Ultra-widefield fundus photograph: 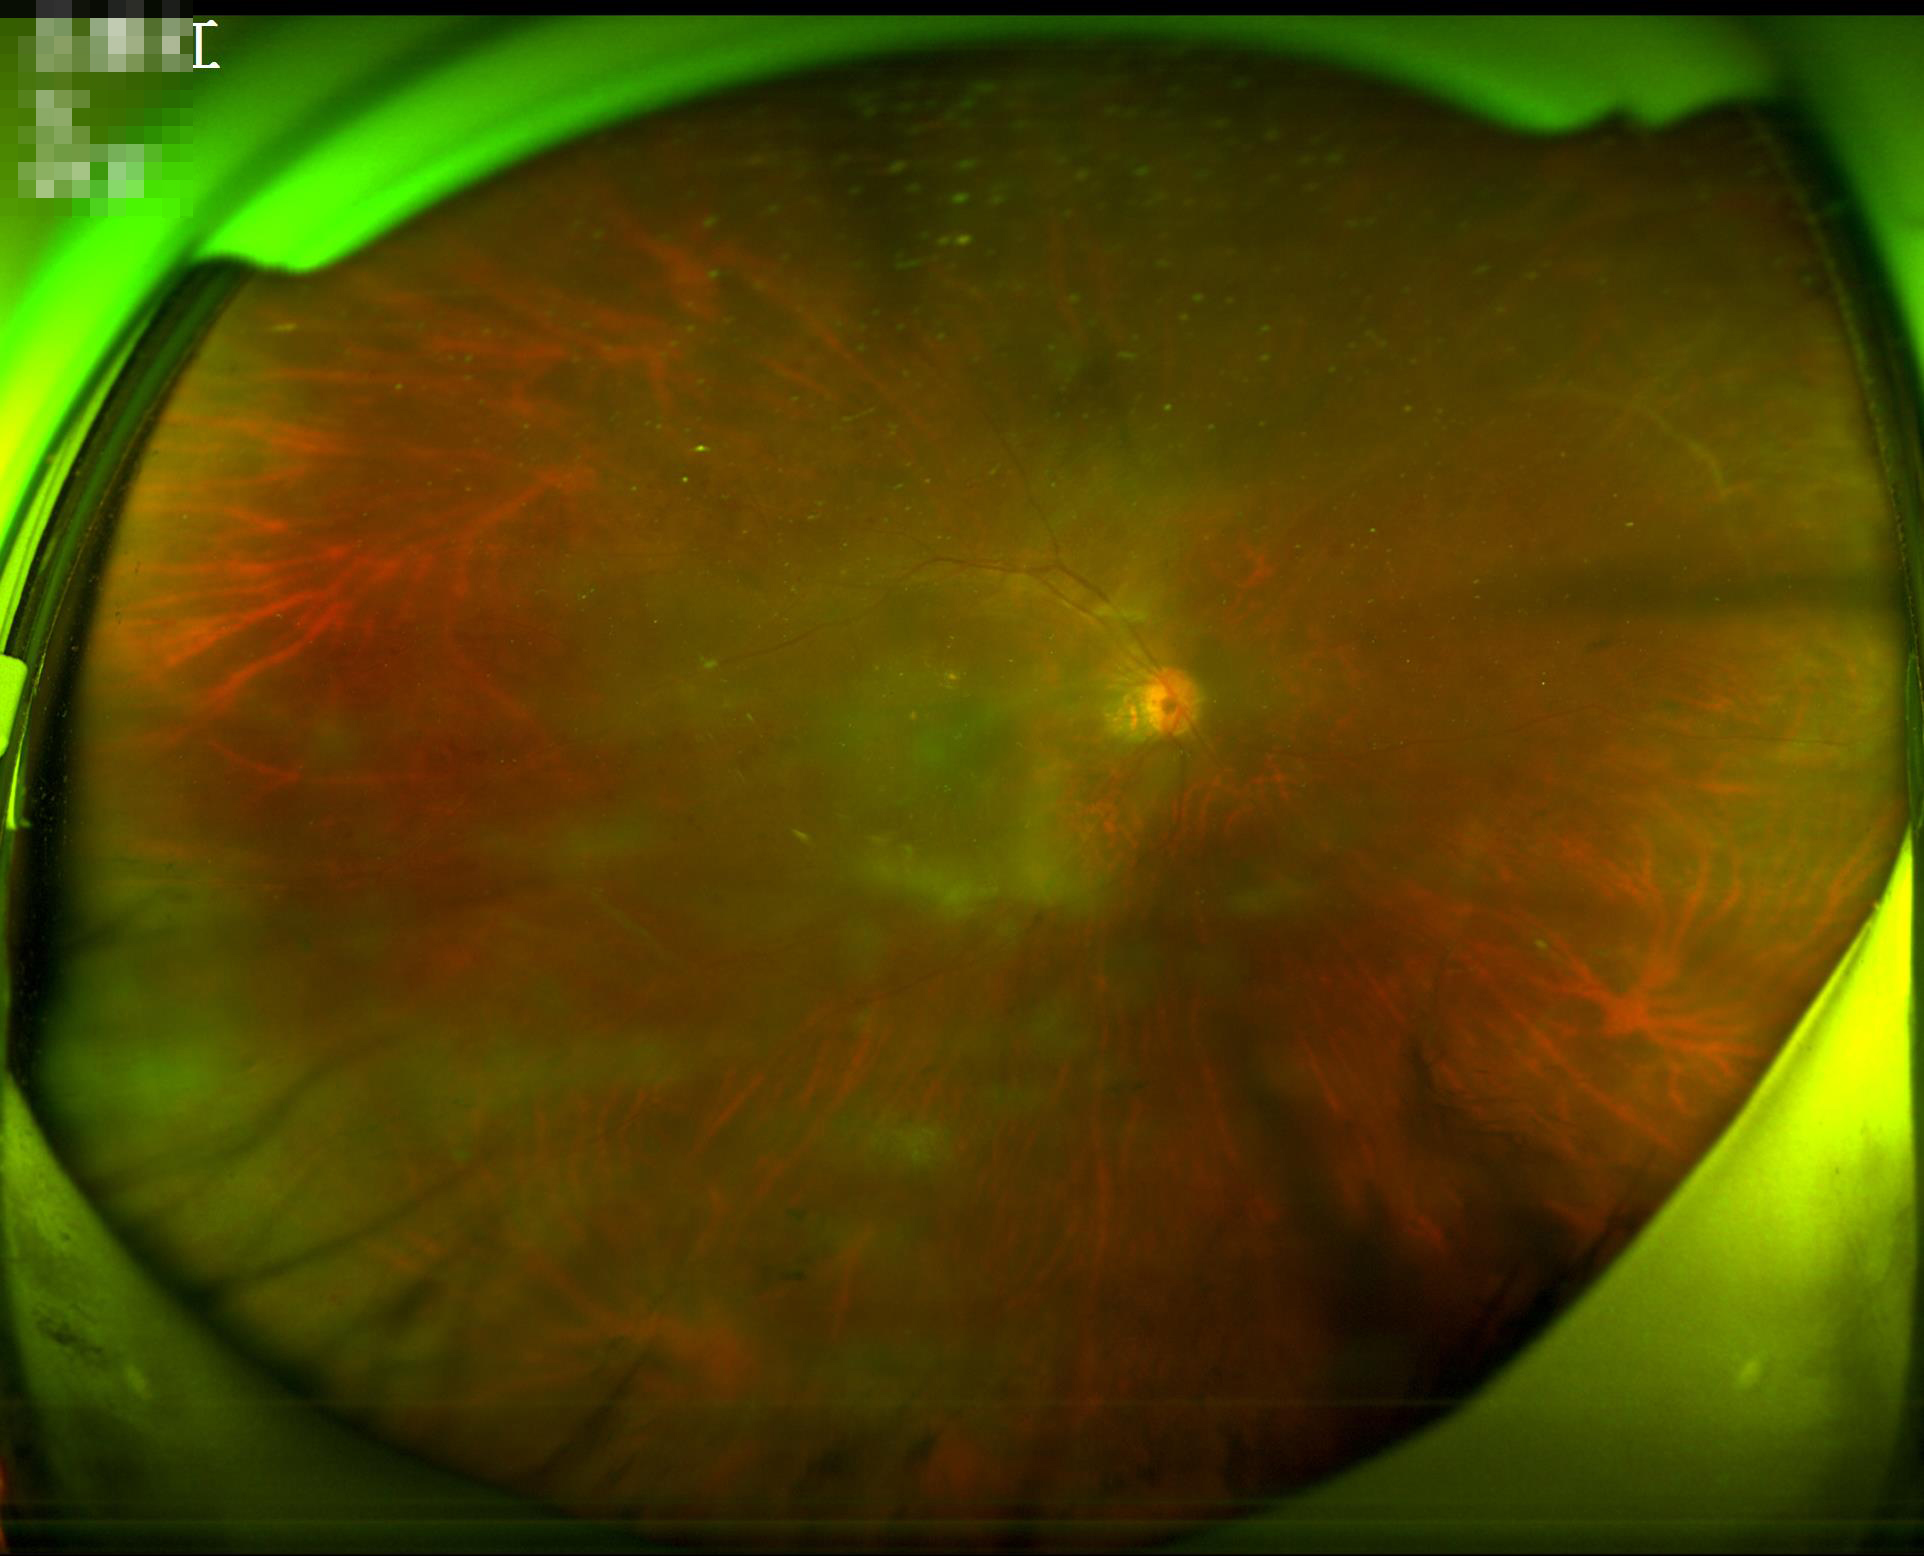

Image quality is suboptimal.
Contrast is low.
Even illumination with no color cast.
The image is blurry.